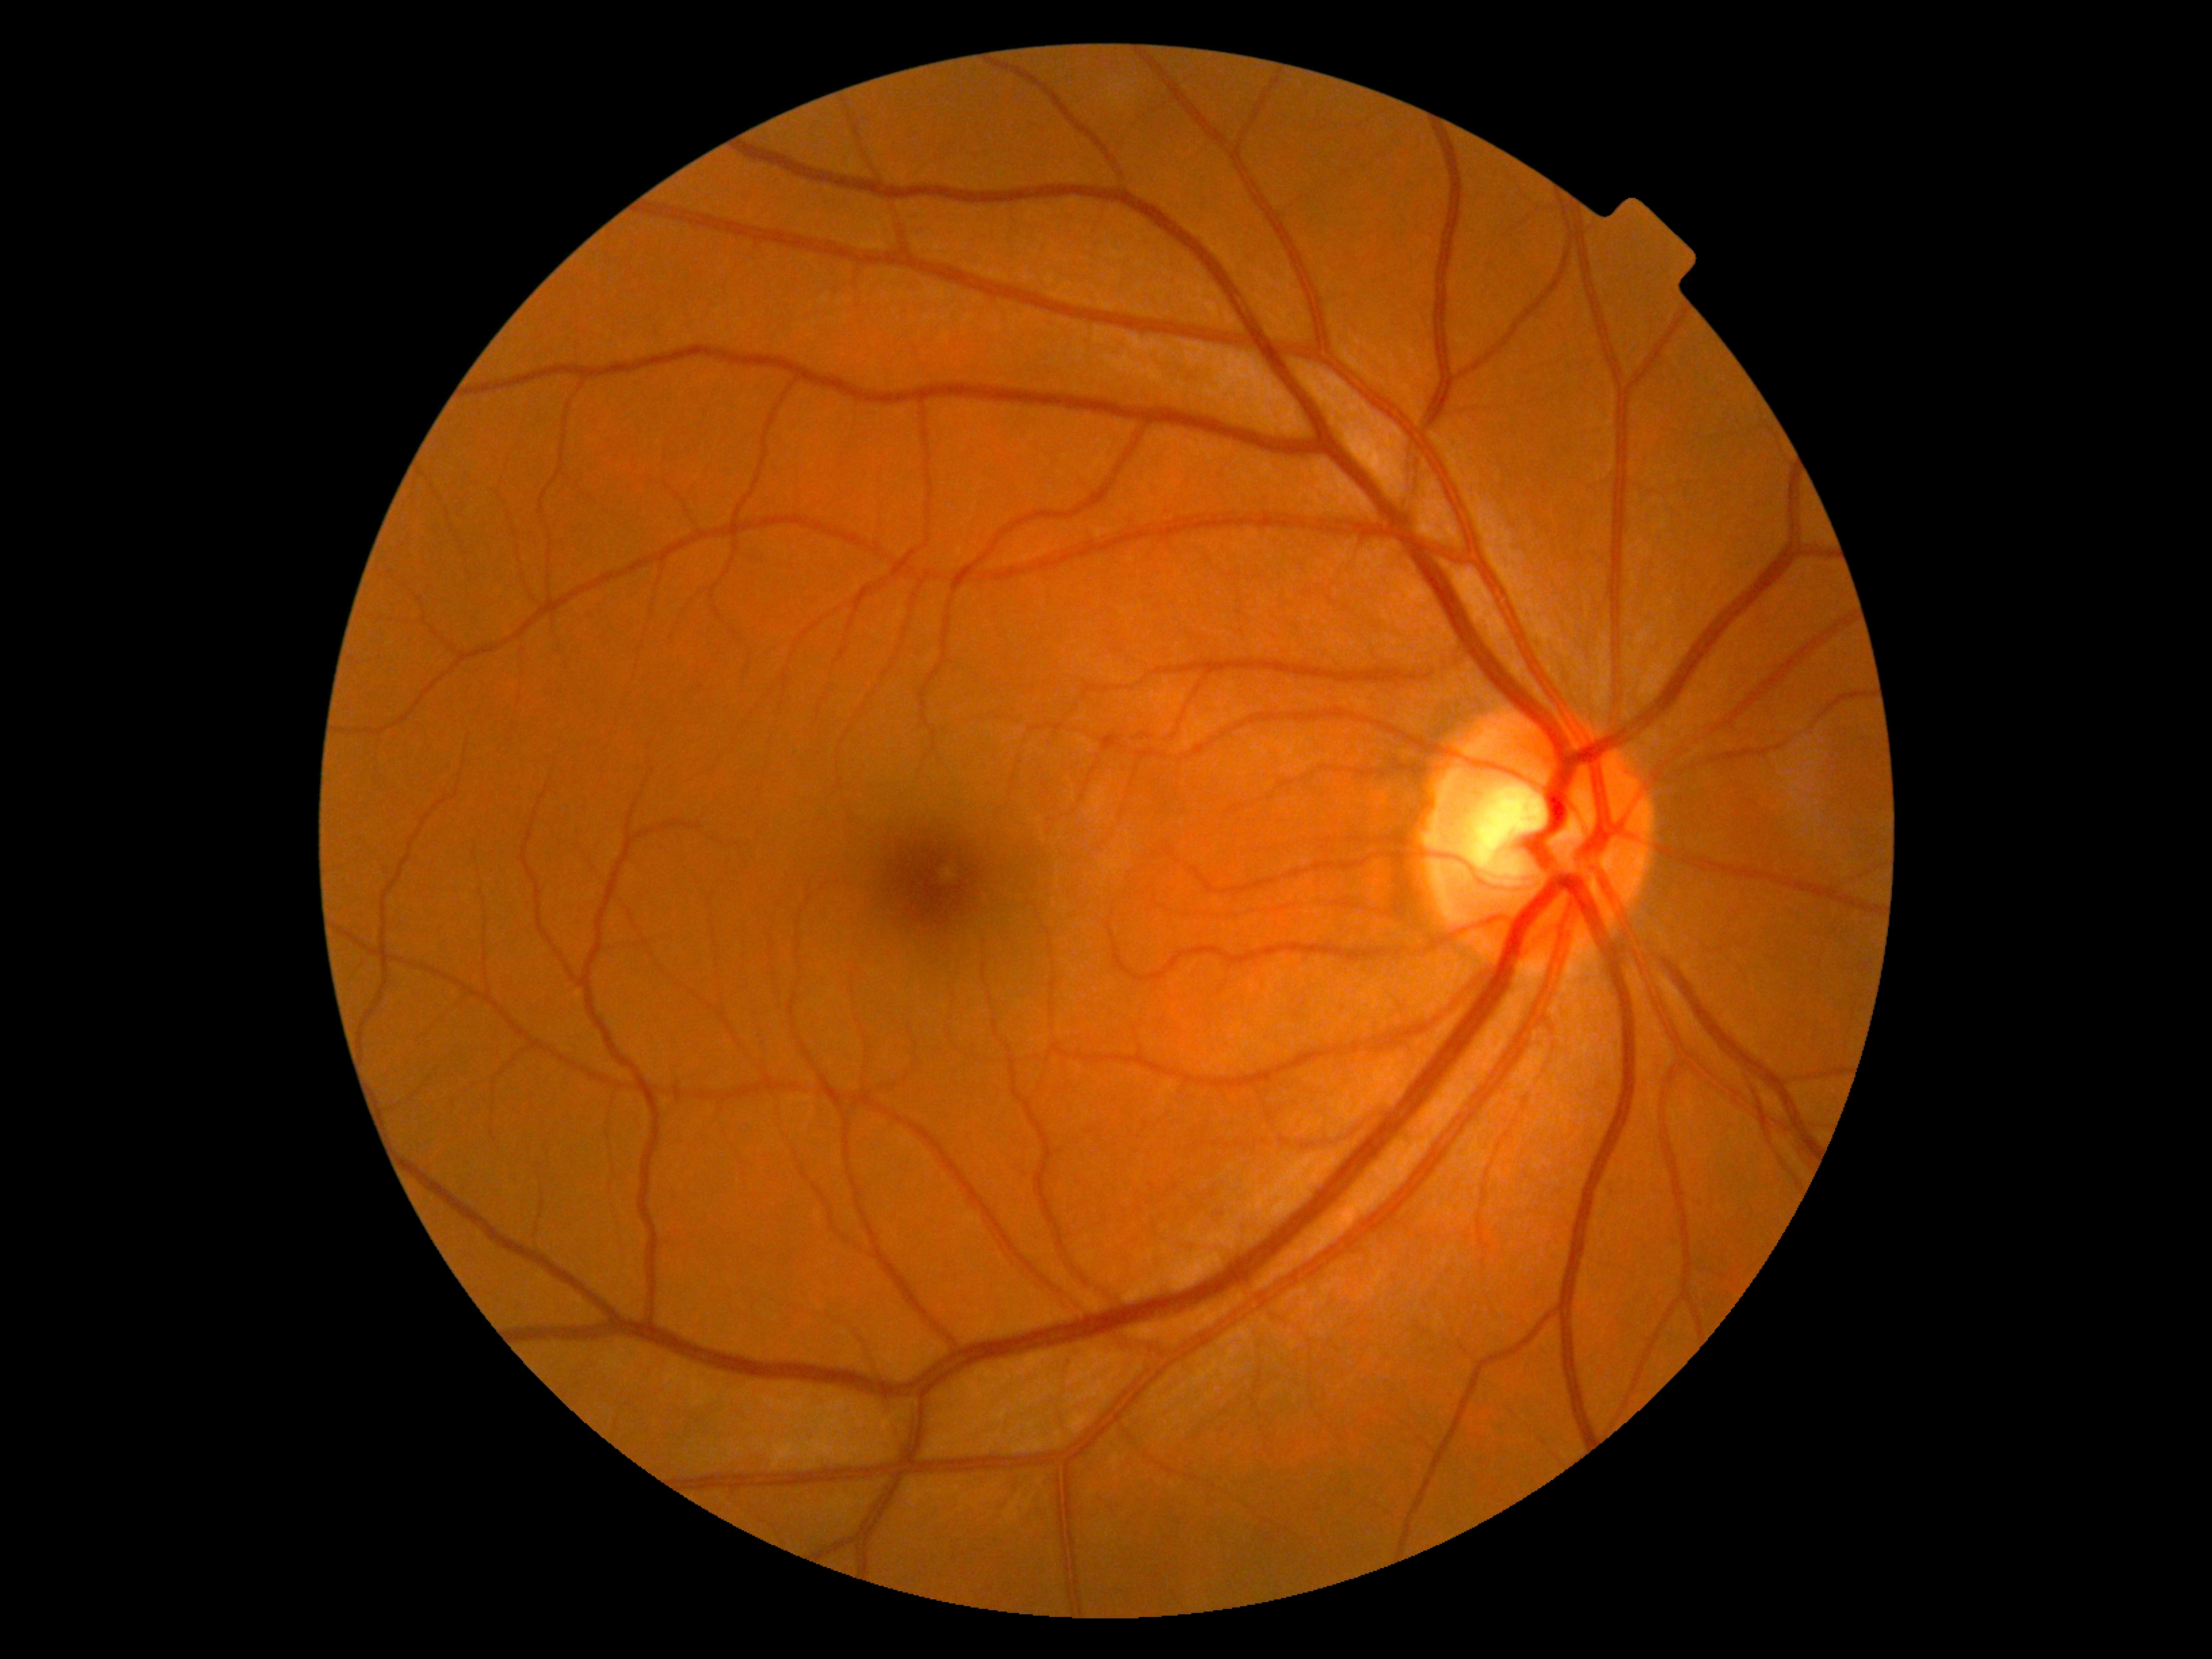
No DR findings. Diabetic retinopathy (DR) is grade 0 (no apparent retinopathy).